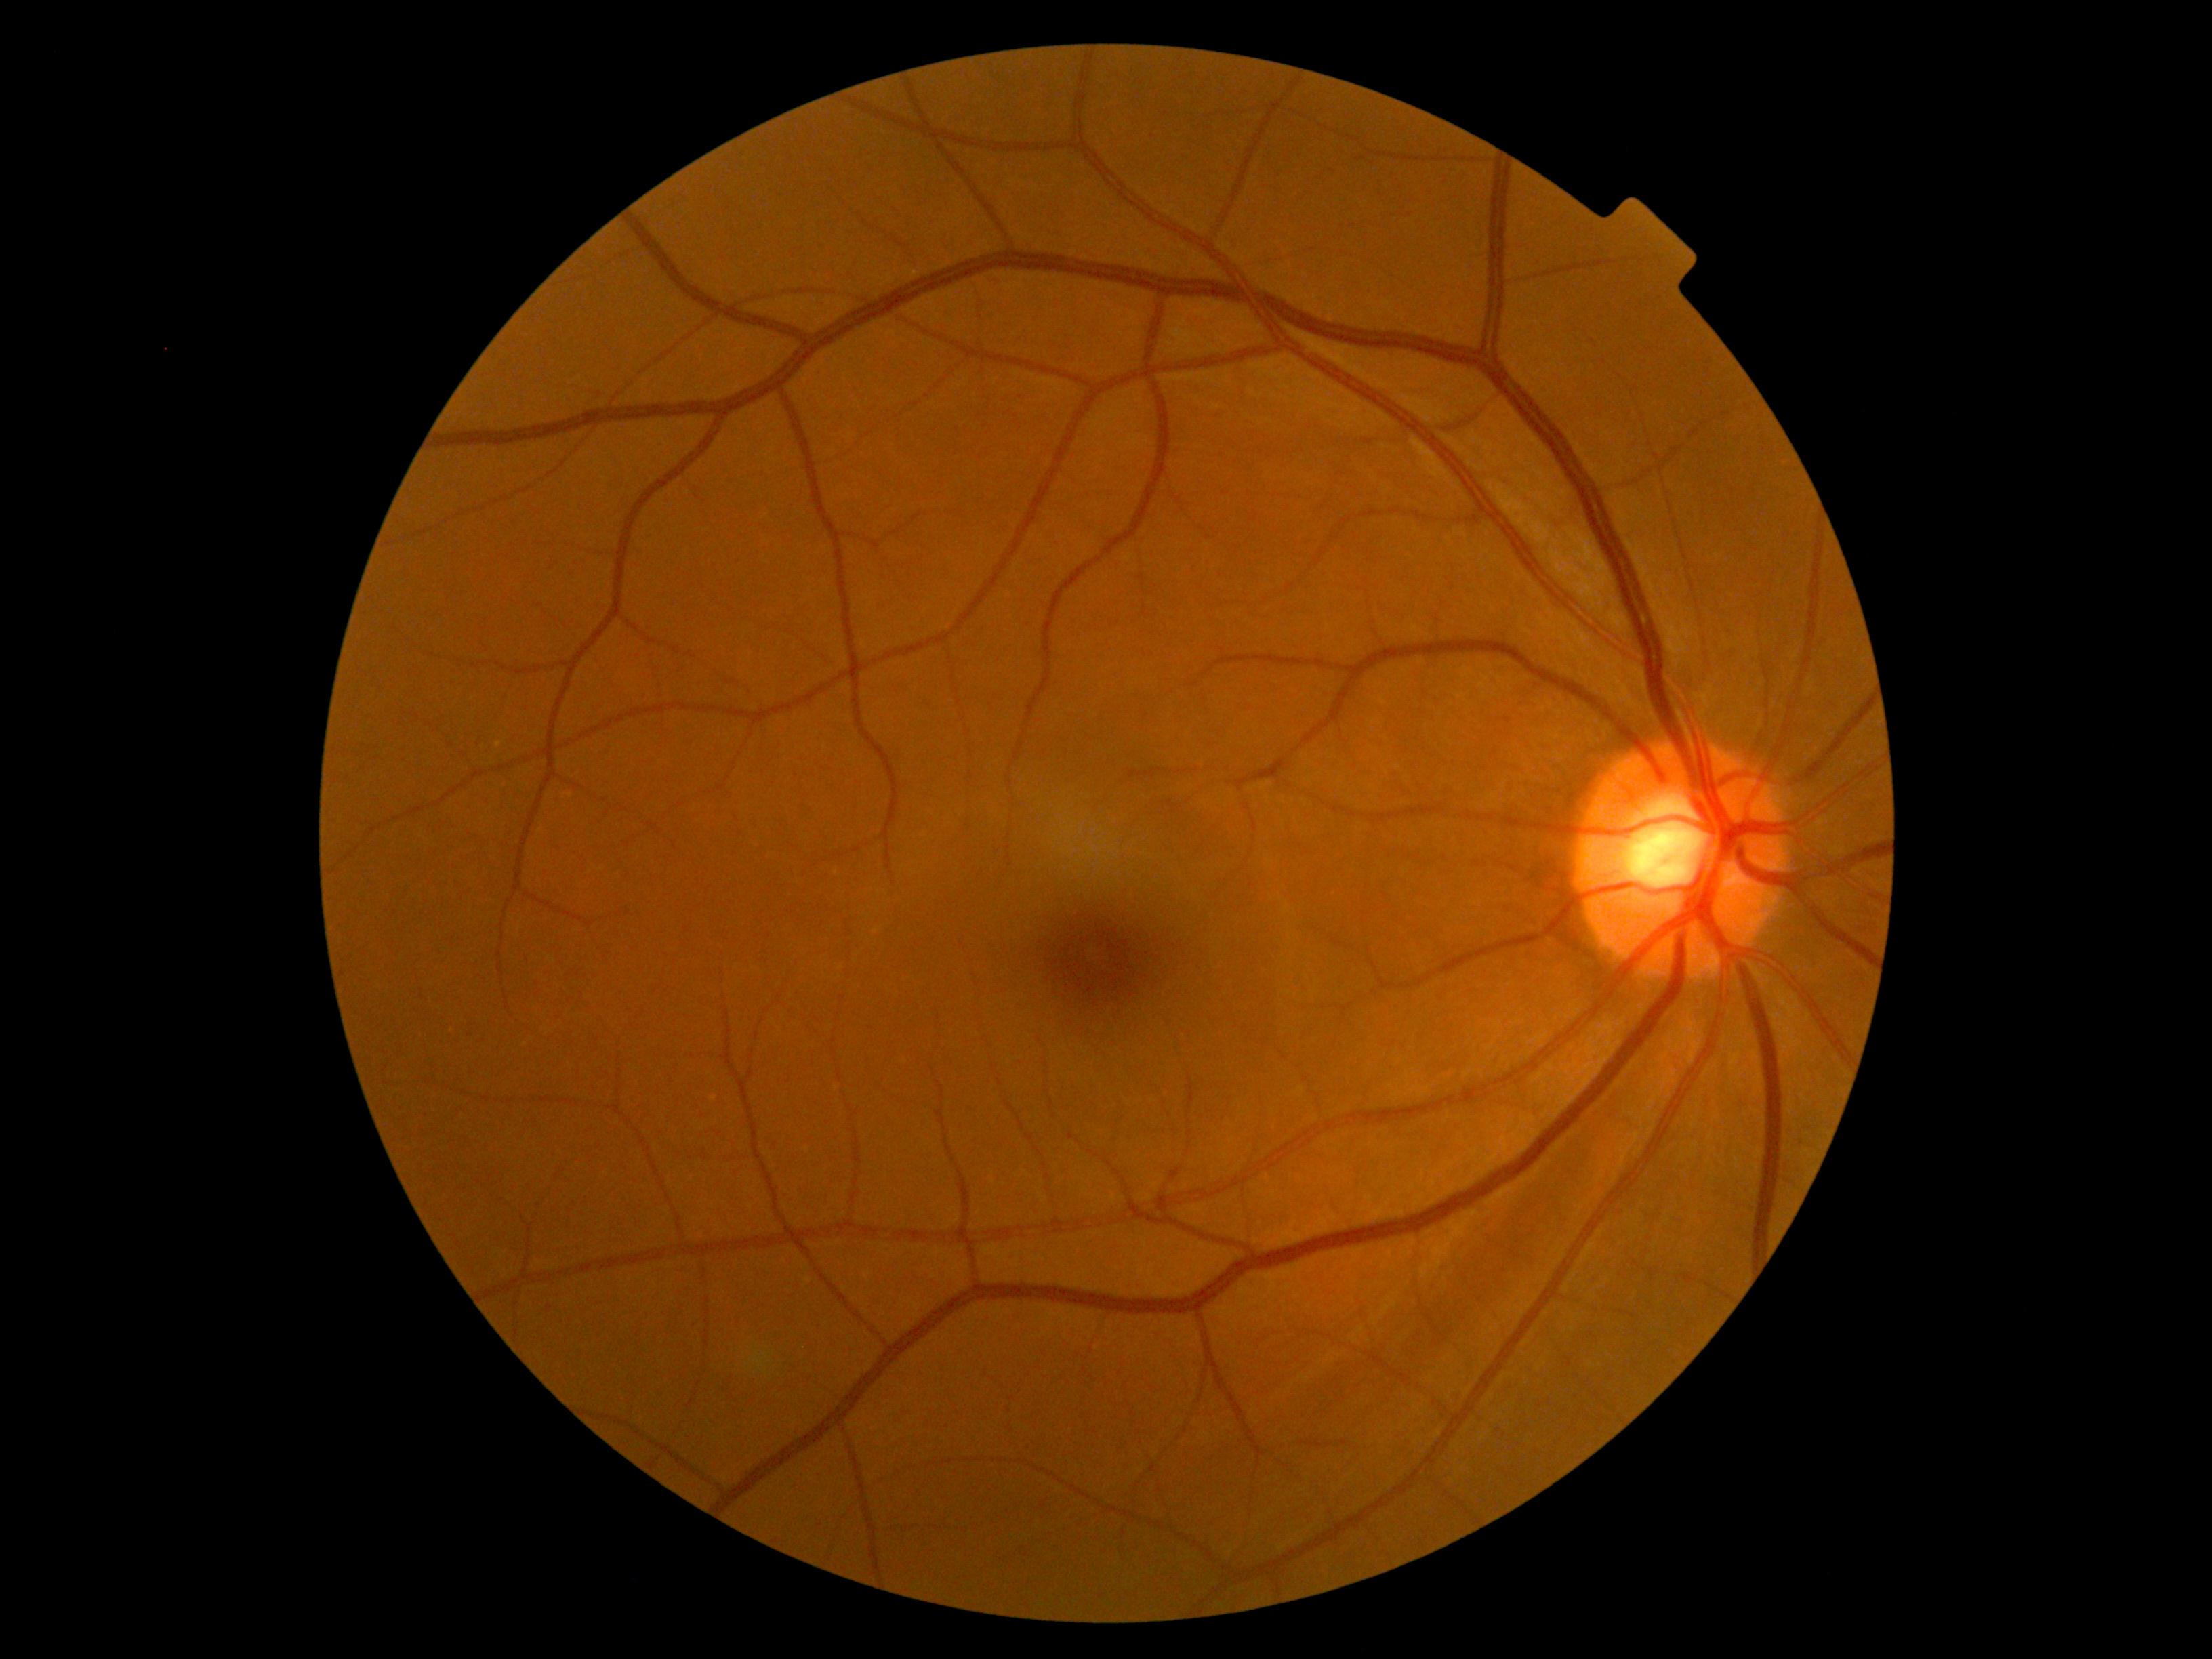
DR severity: grade 0.